Captured with the Phoenix ICON (100° field of view). Pediatric retinal photograph (wide-field). 1240 by 1240 pixels — 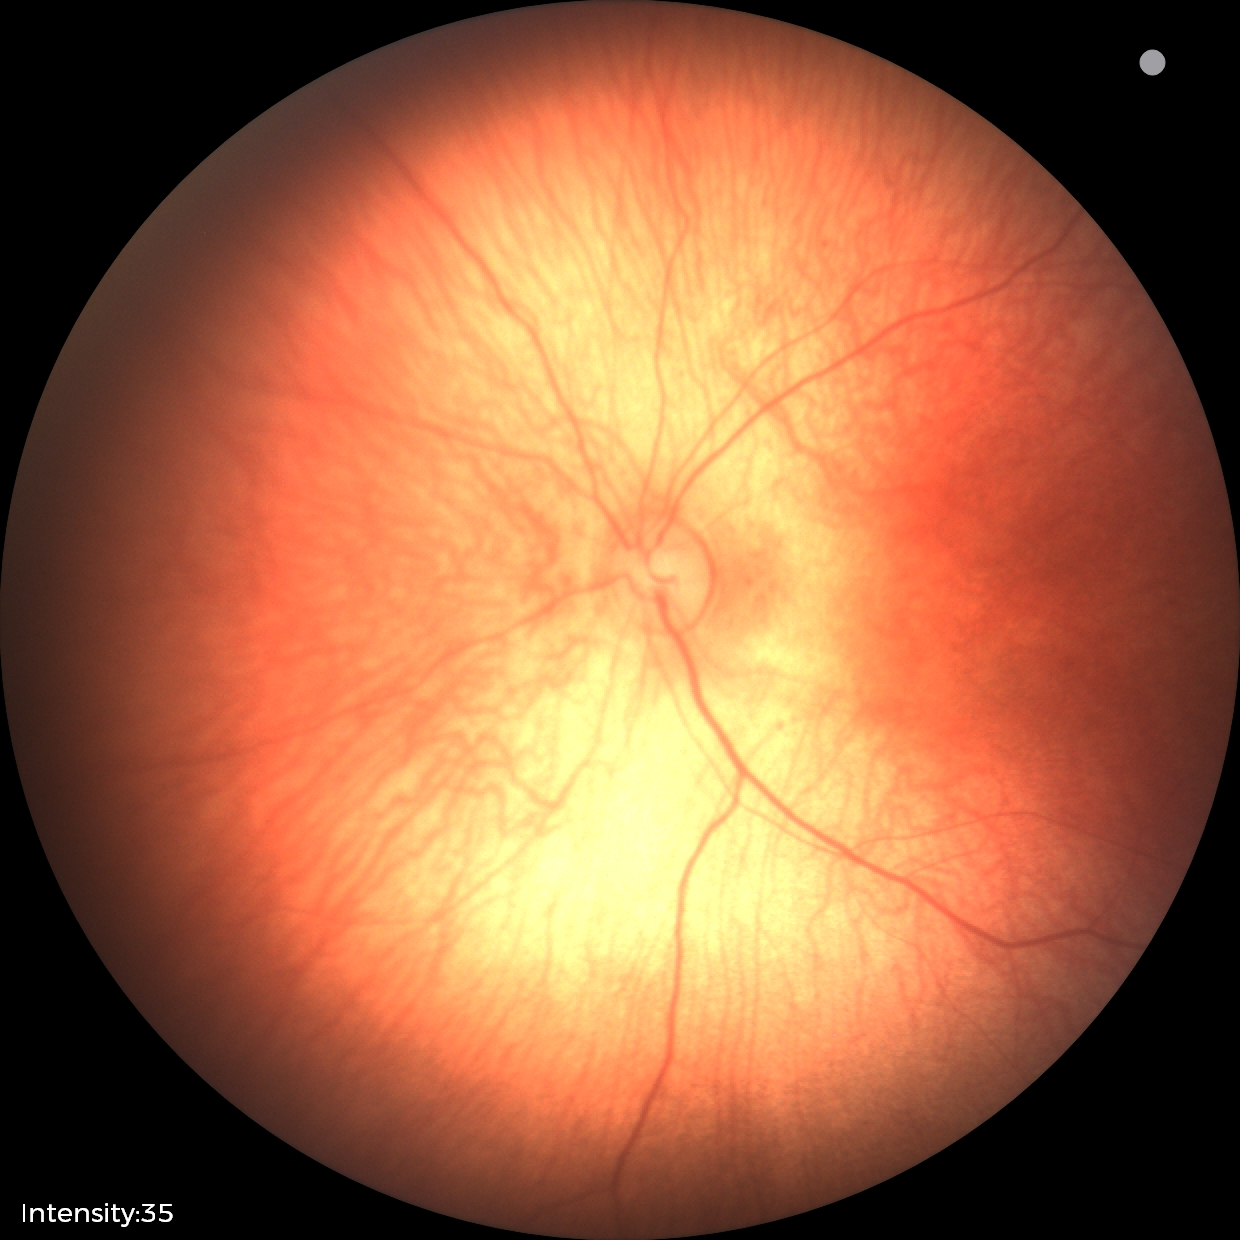
Q: What was the screening finding?
A: physiological finding